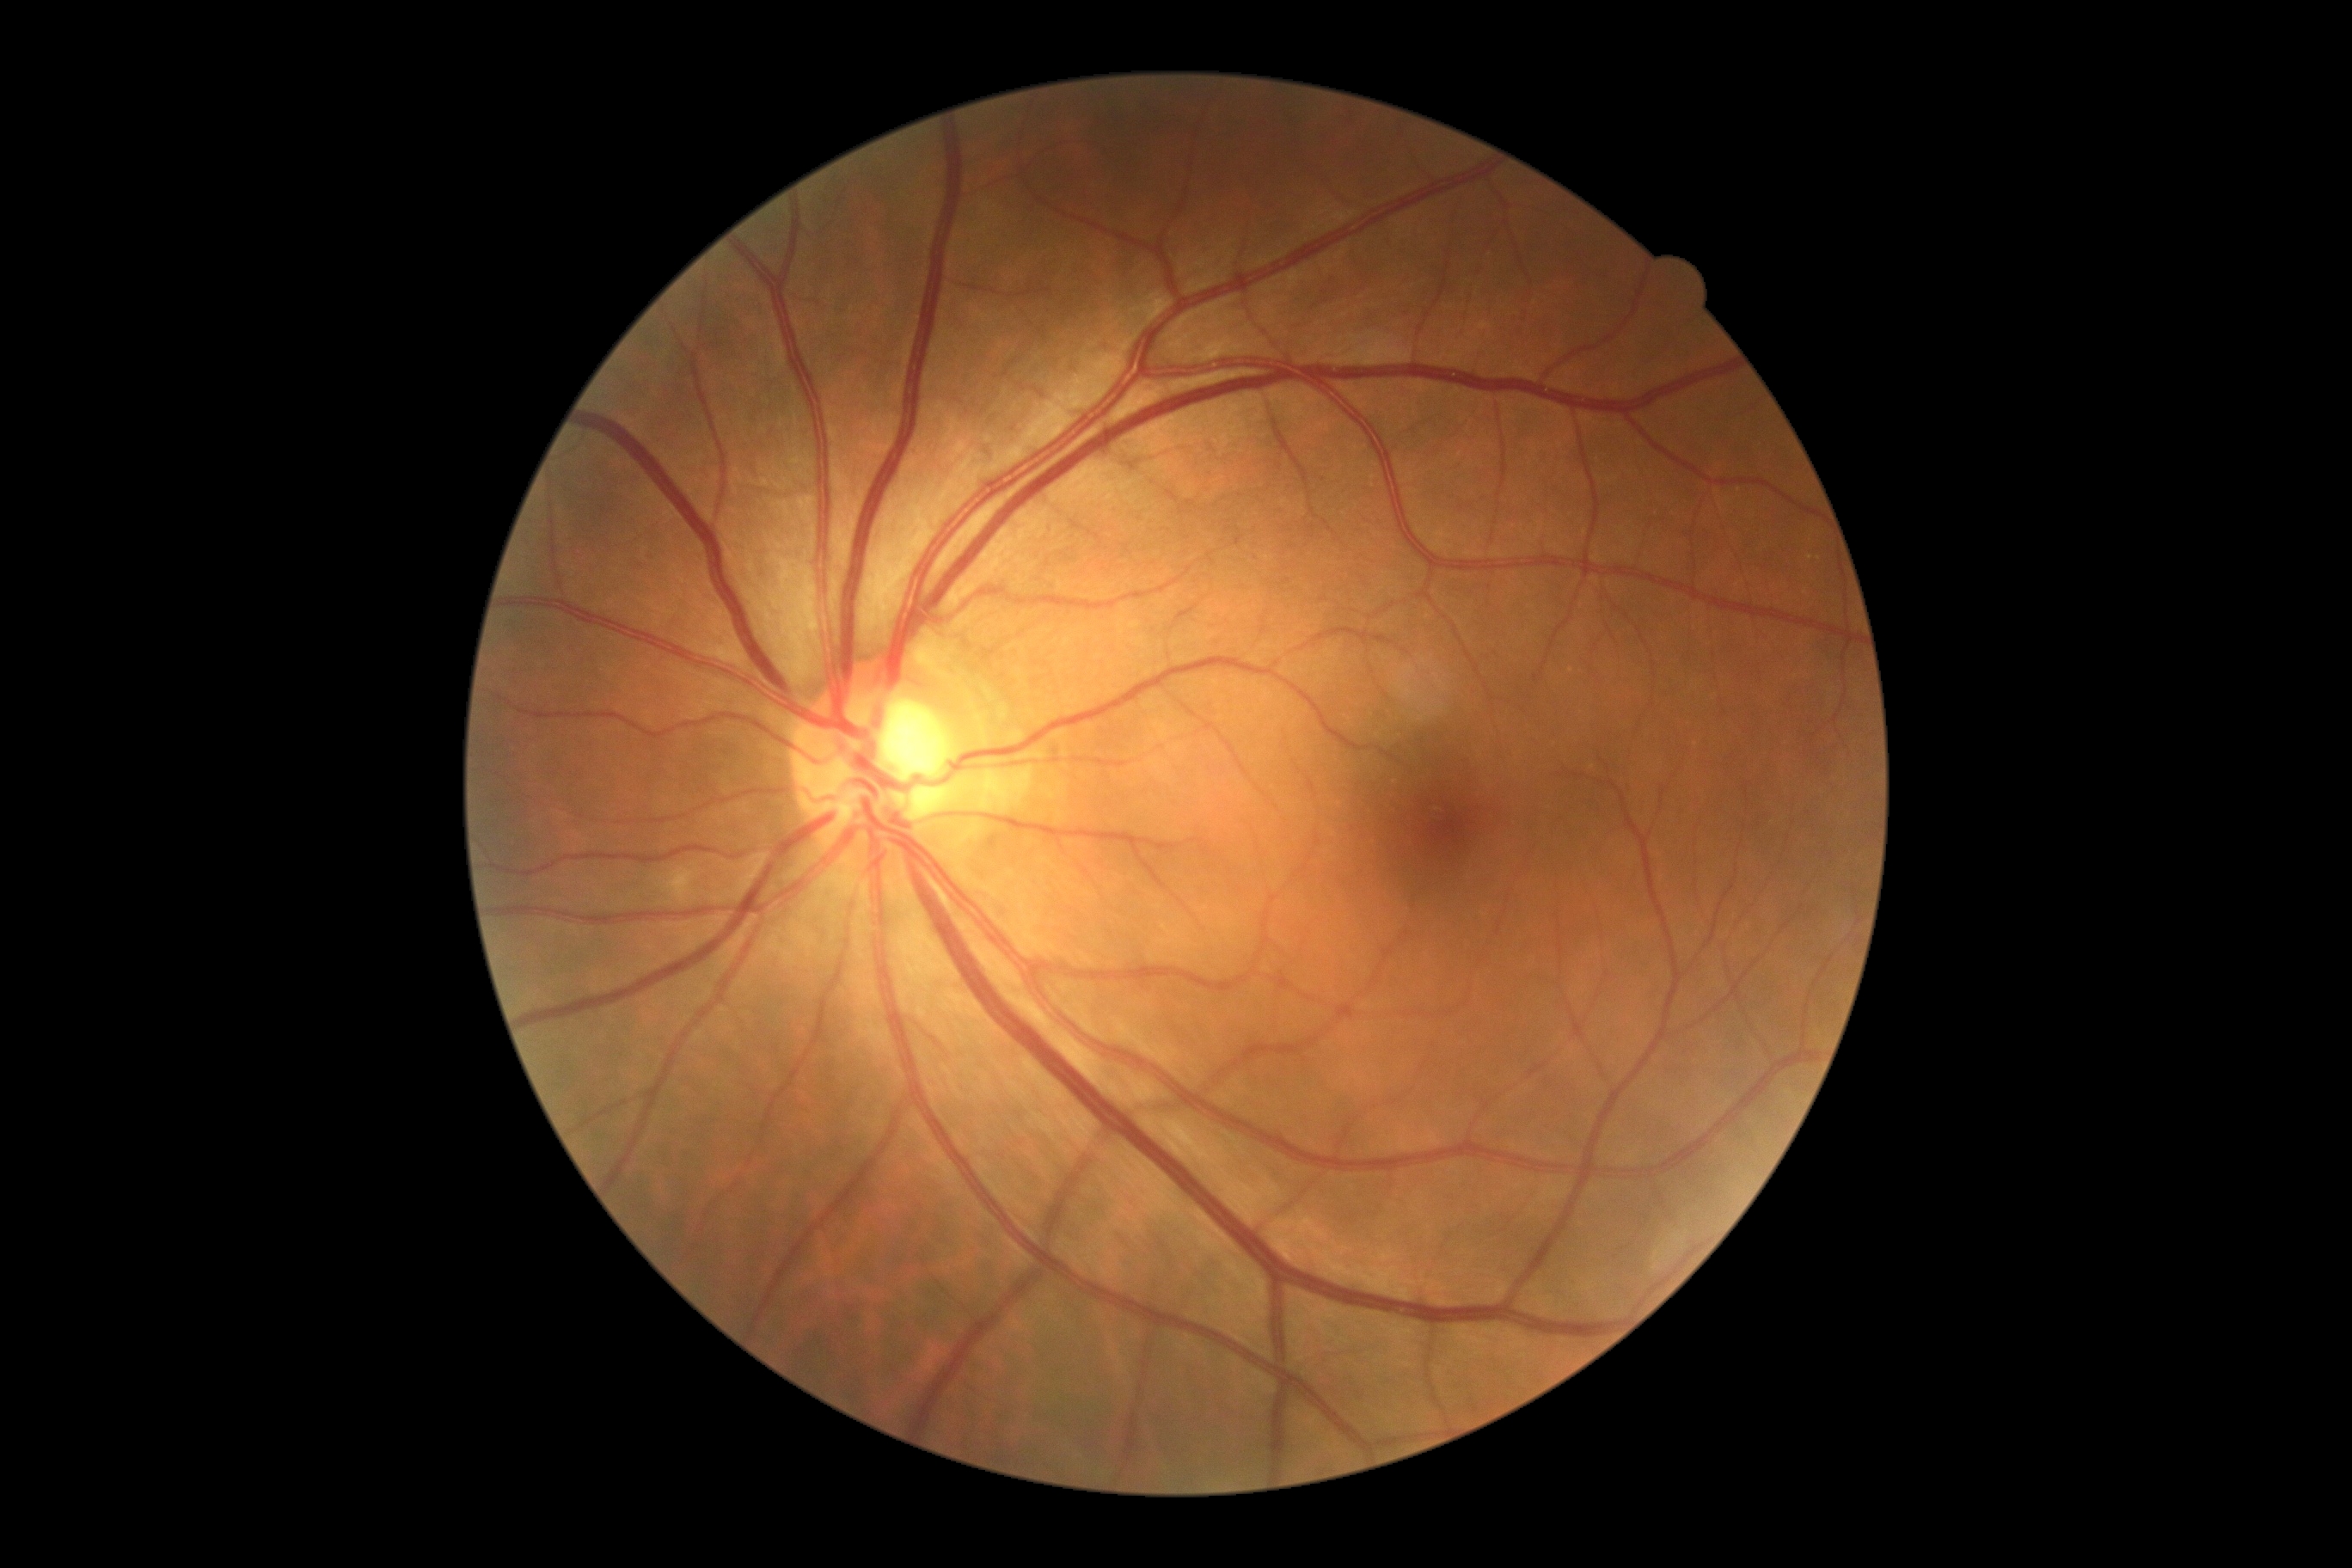

{
  "dr_grade": "0/4"
}